Color fundus photograph: 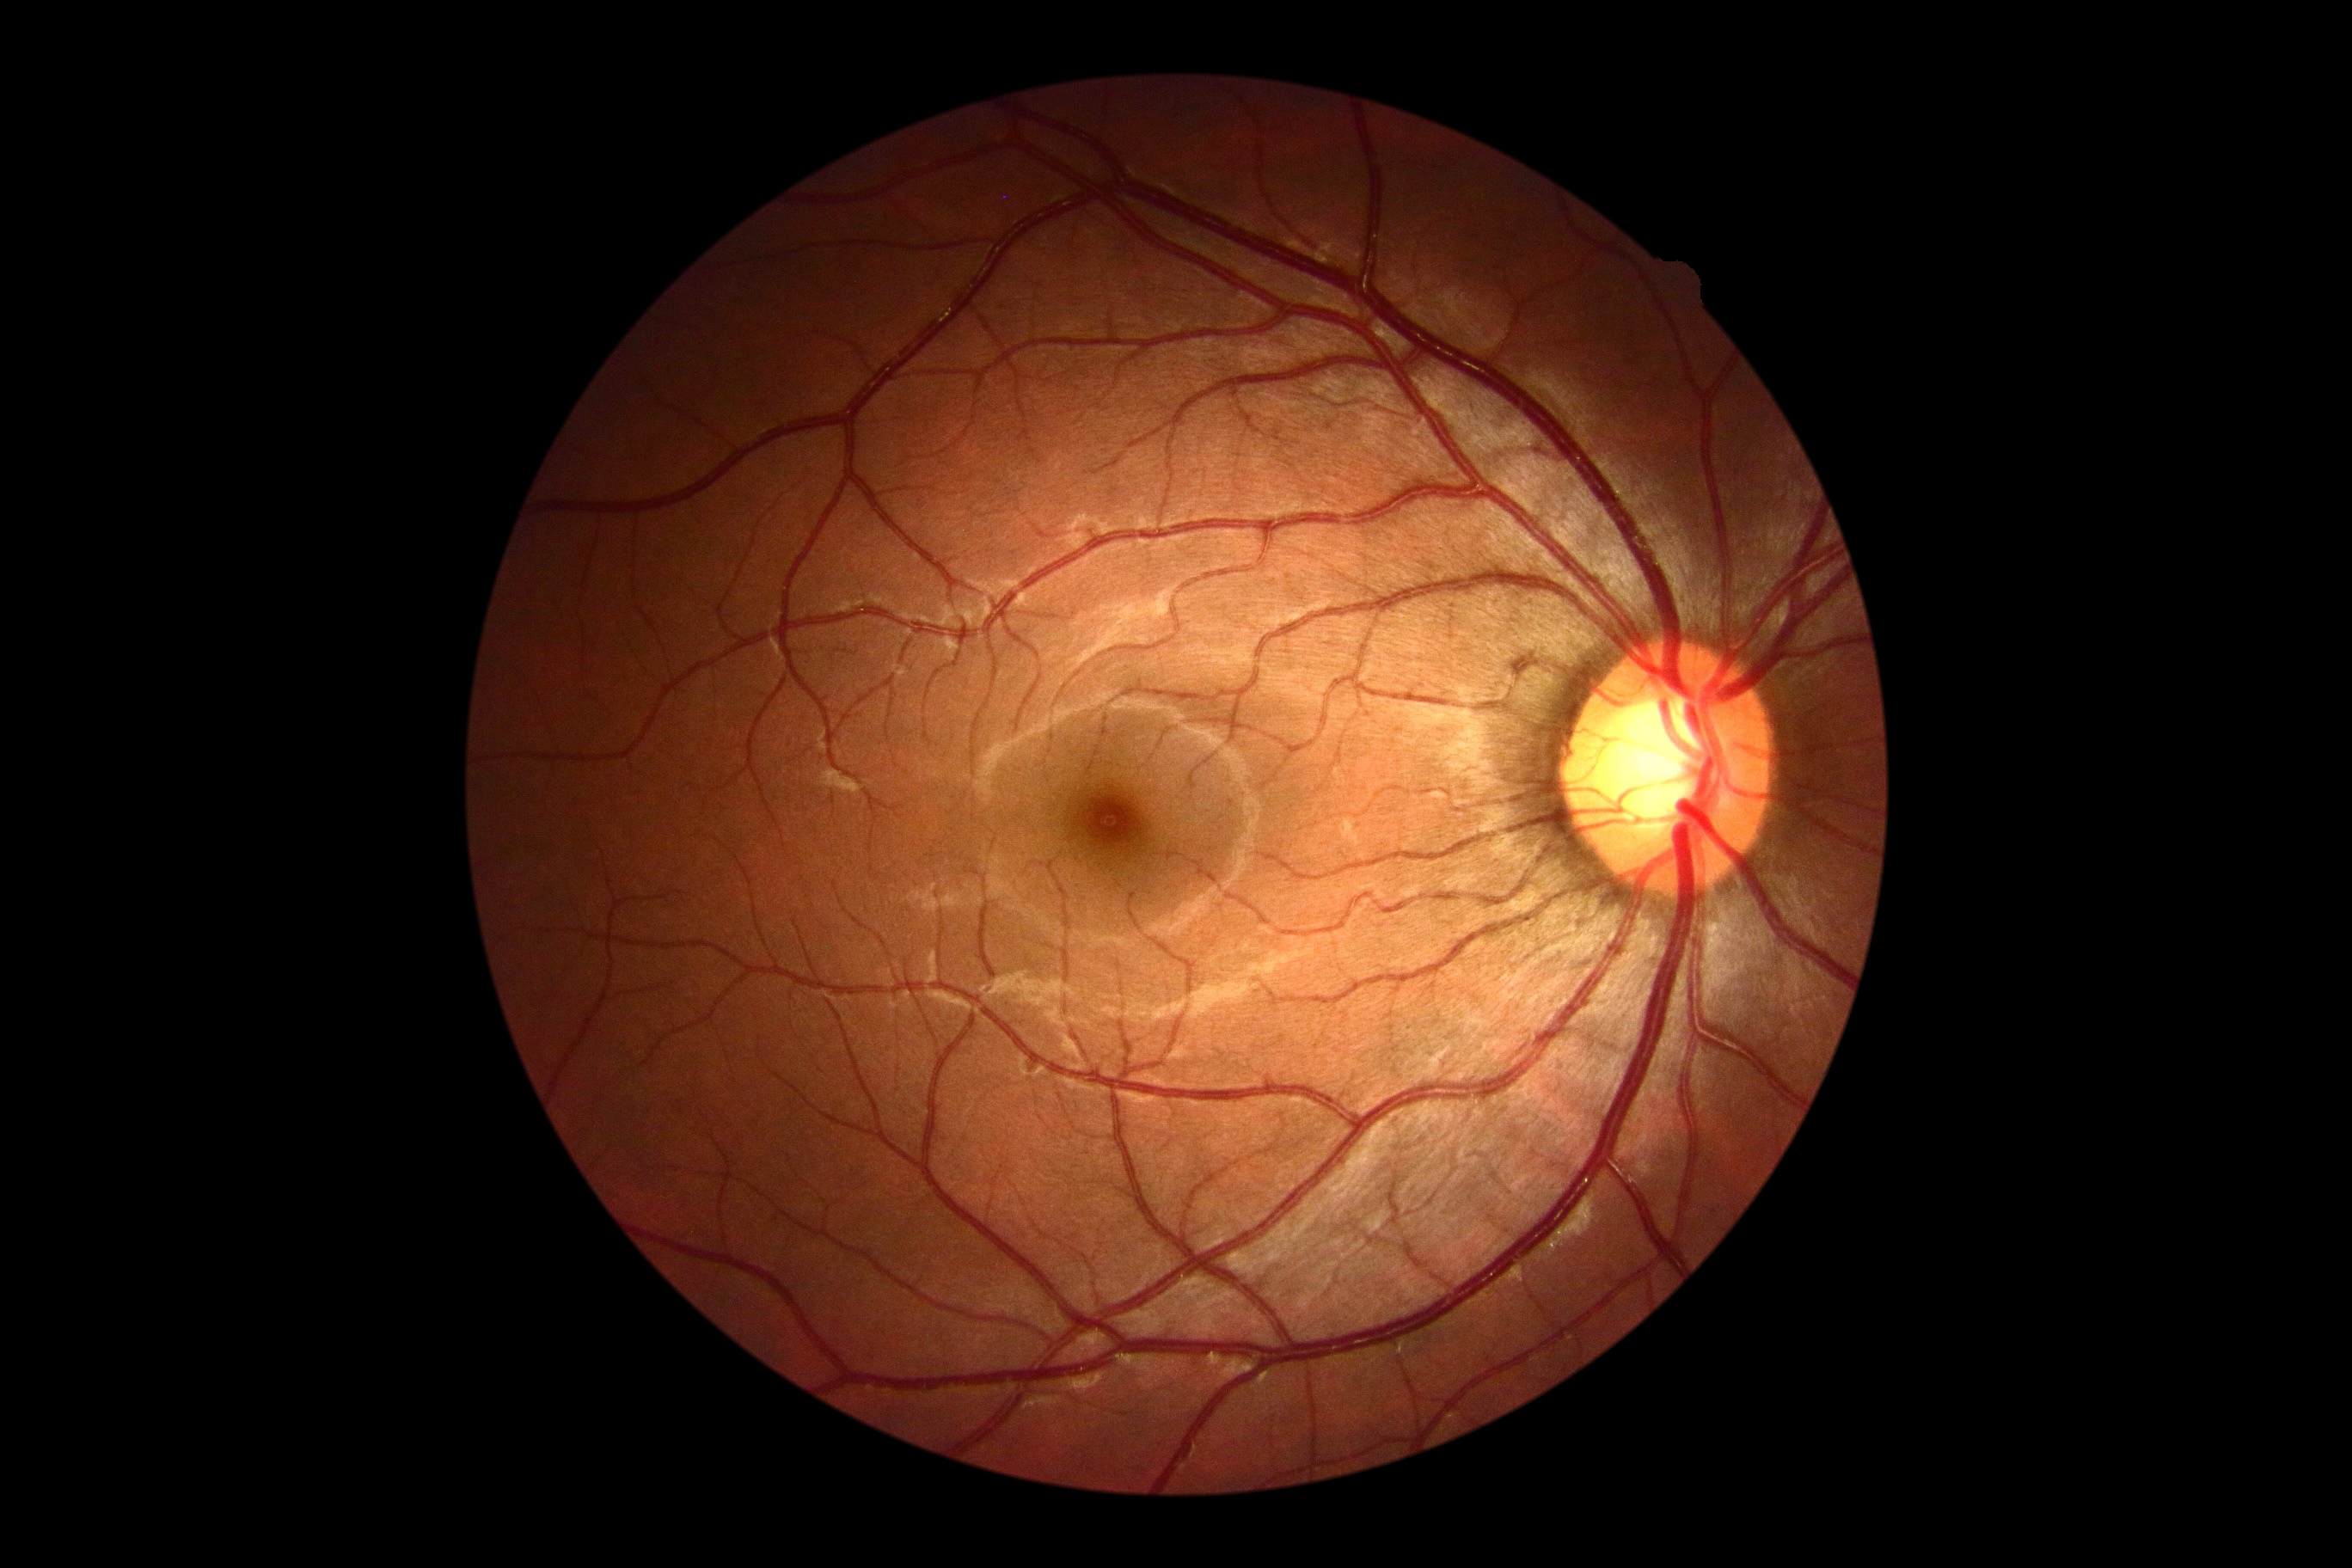
Diabetic retinopathy (DR) is 0/4.